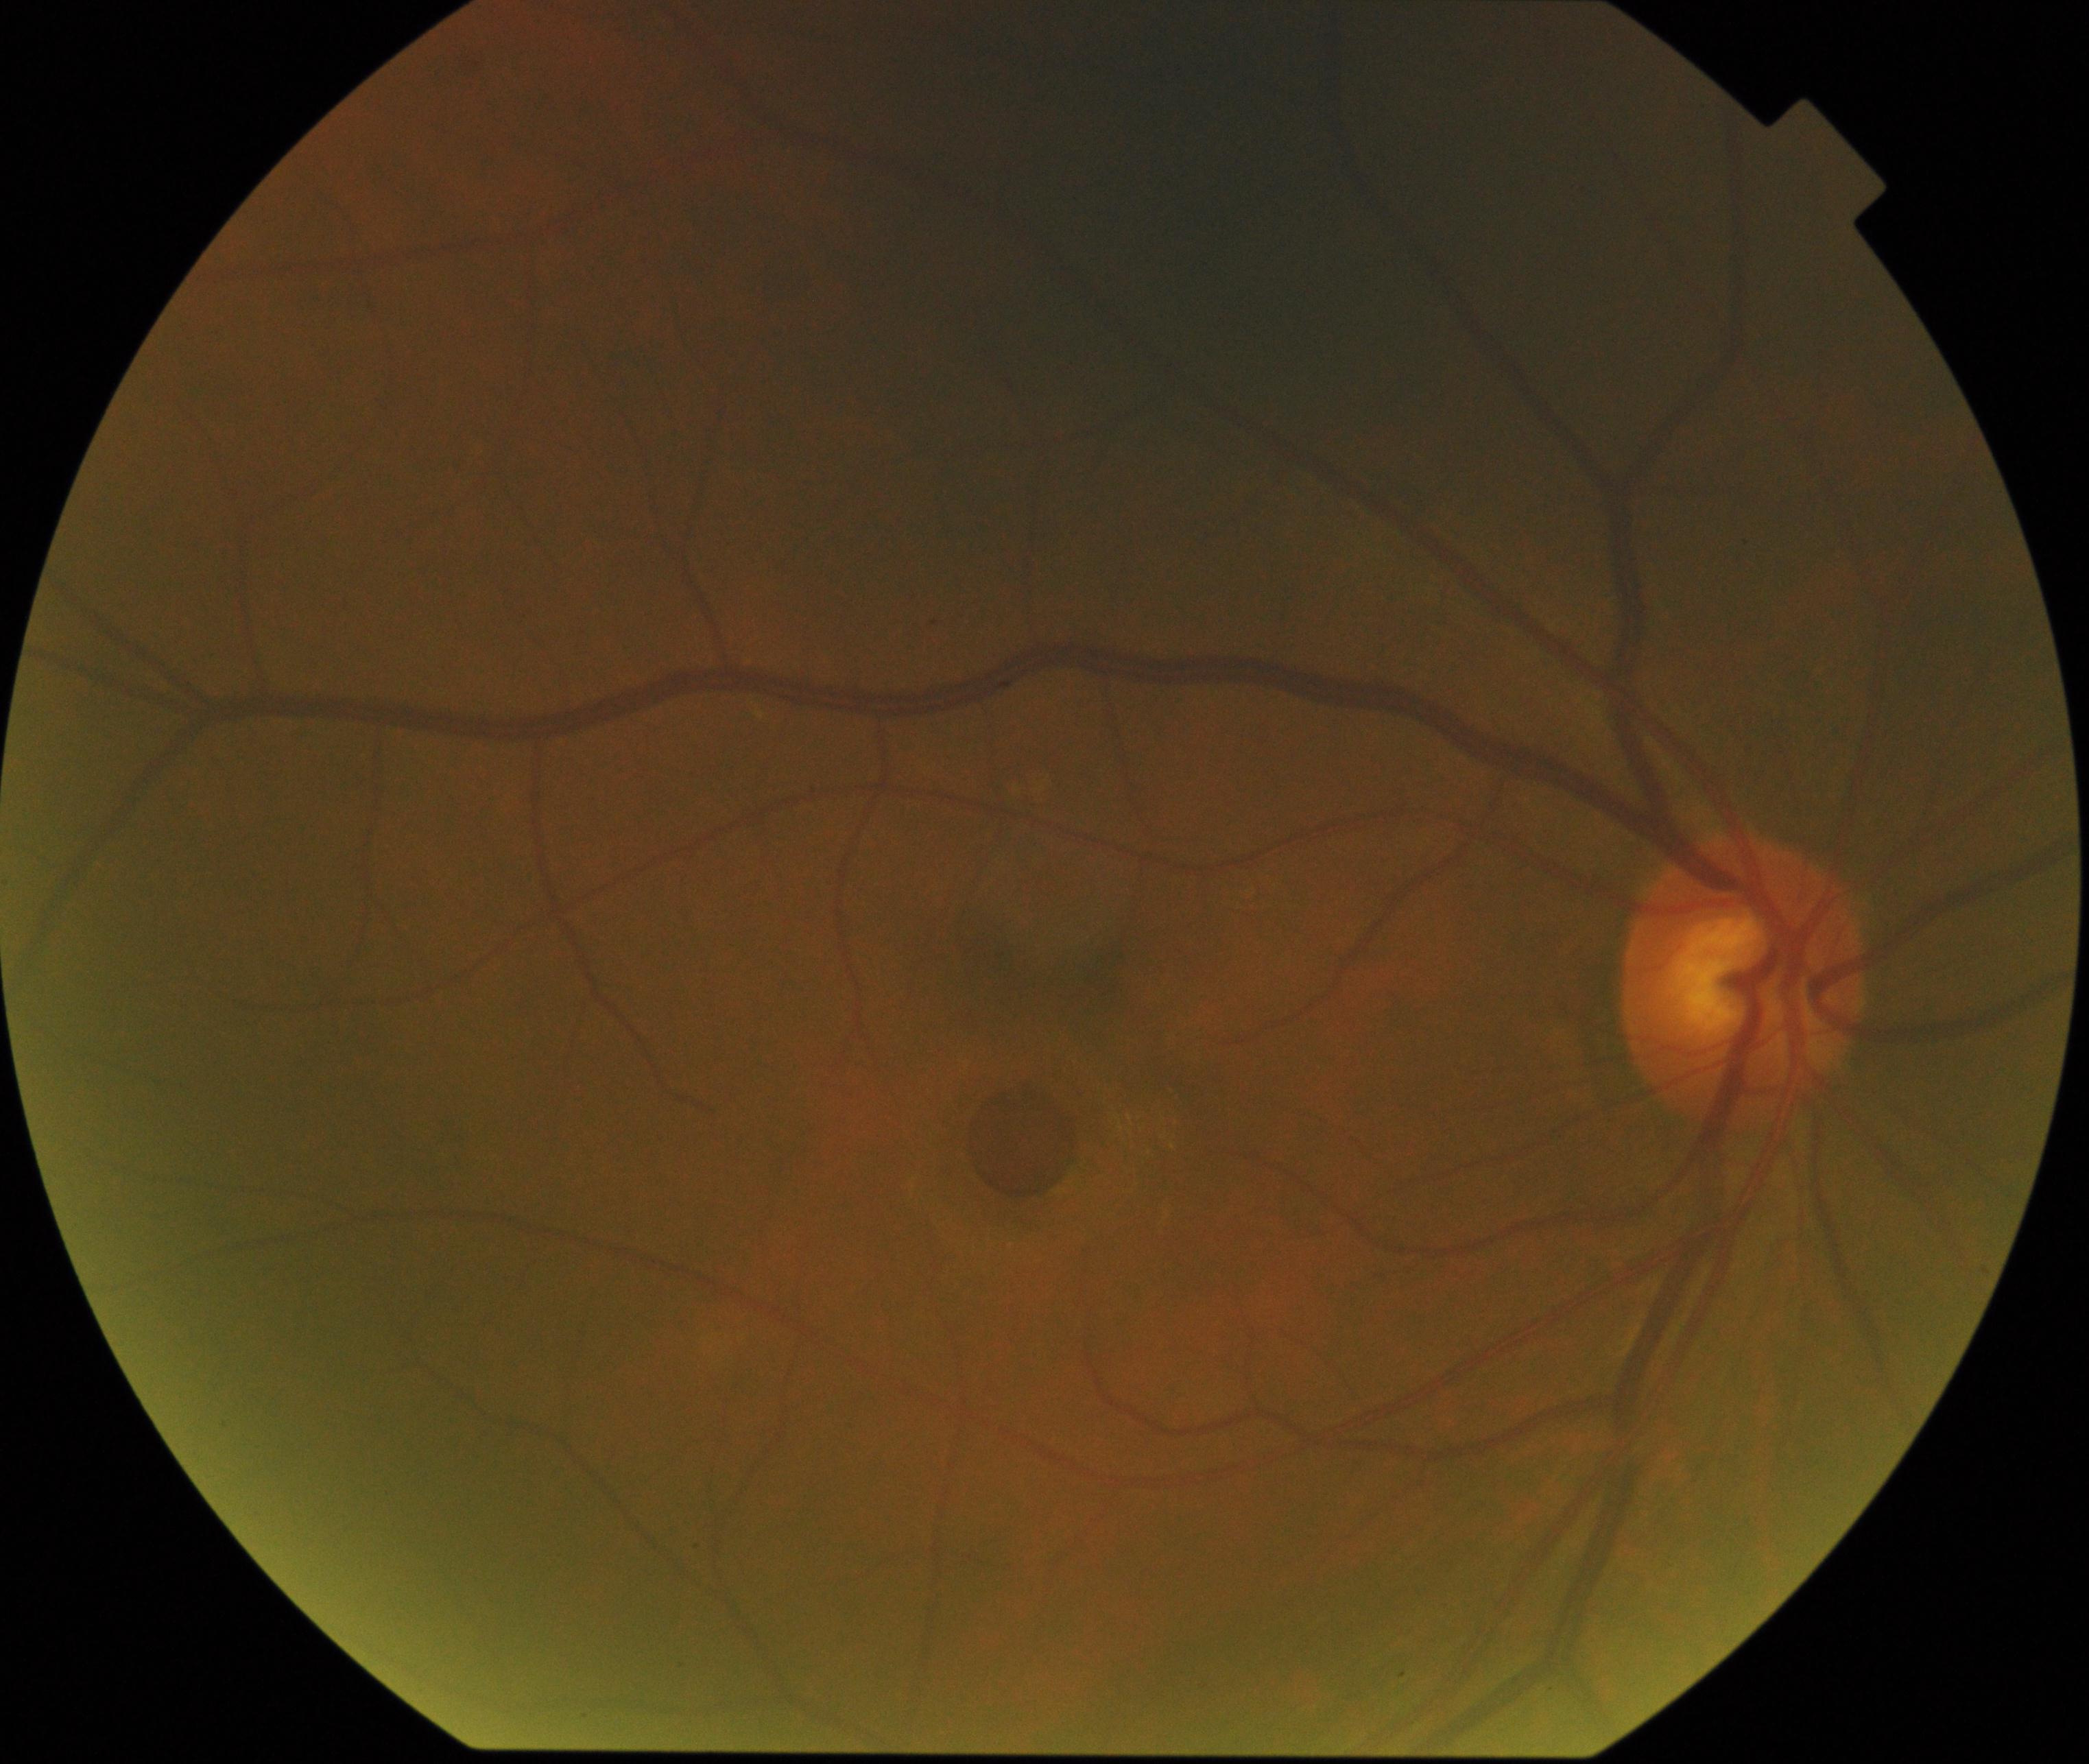
Demonstrates macular hole.